2228x1652px:
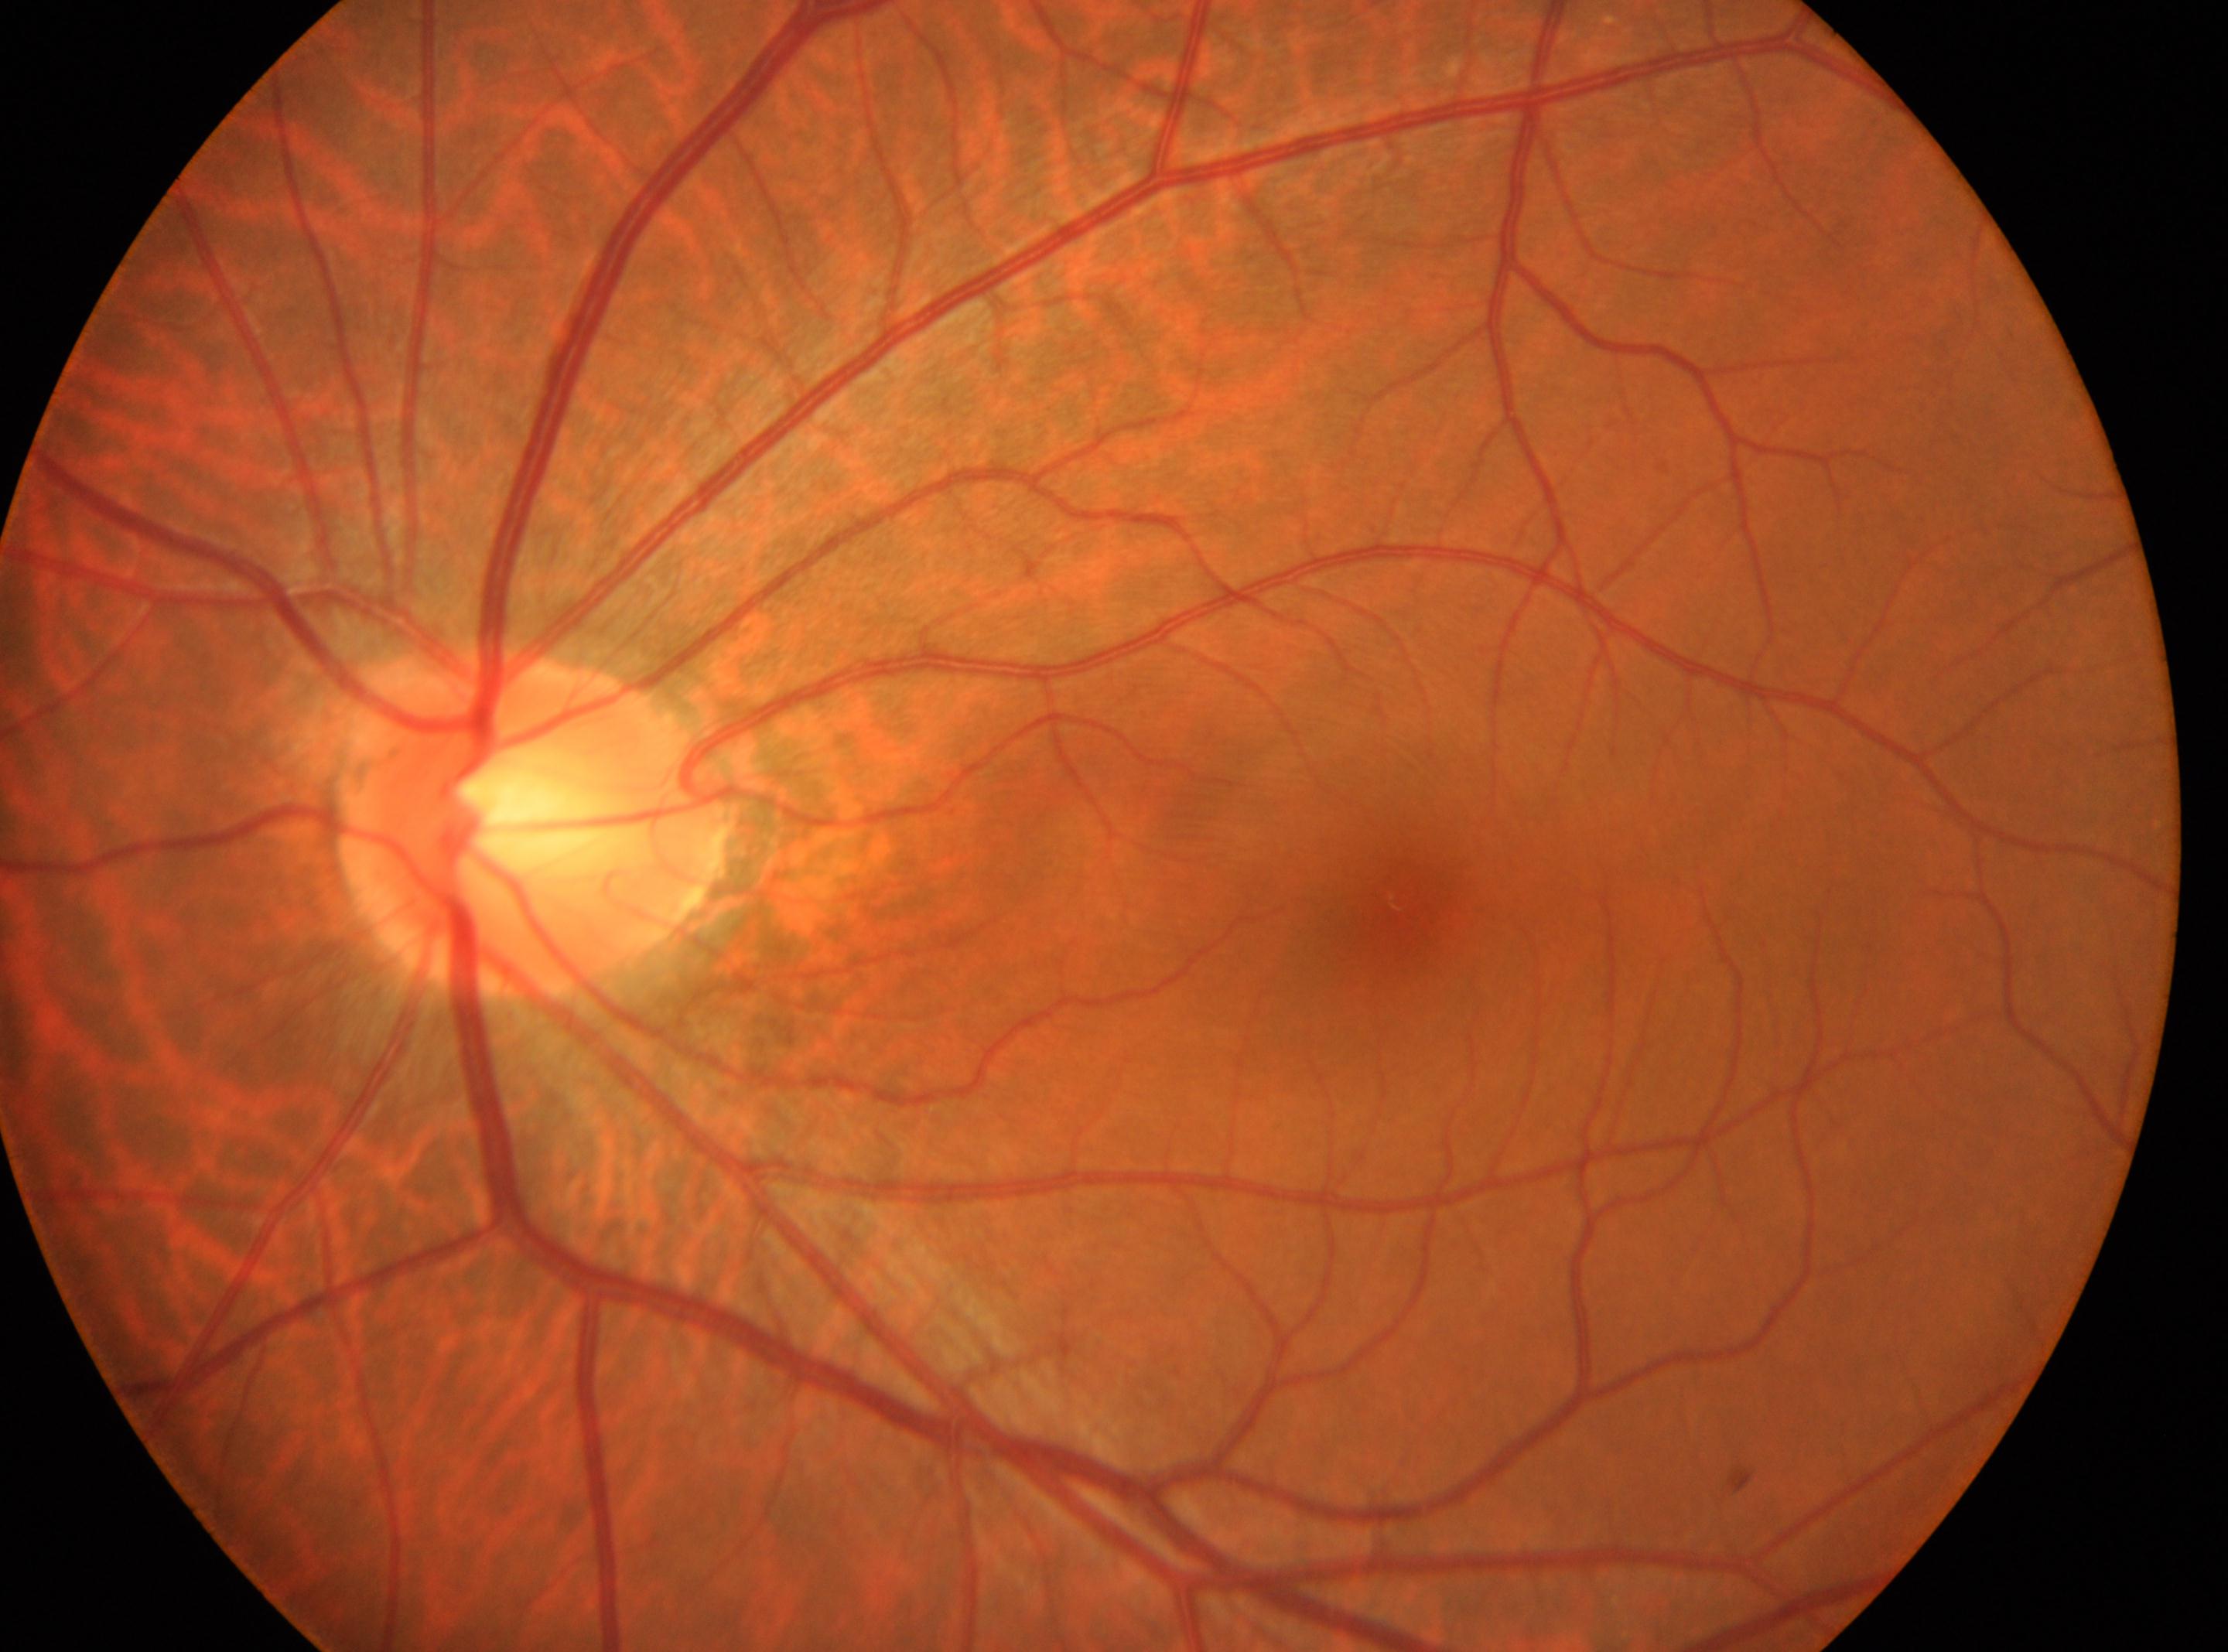

foveal center=(x=1399, y=899)
diabetic retinopathy grade=no apparent retinopathy (0)
the left eye
optic disc center=(x=536, y=828)